Retinal fundus photograph · 2352 x 1568 pixels · 45-degree field of view
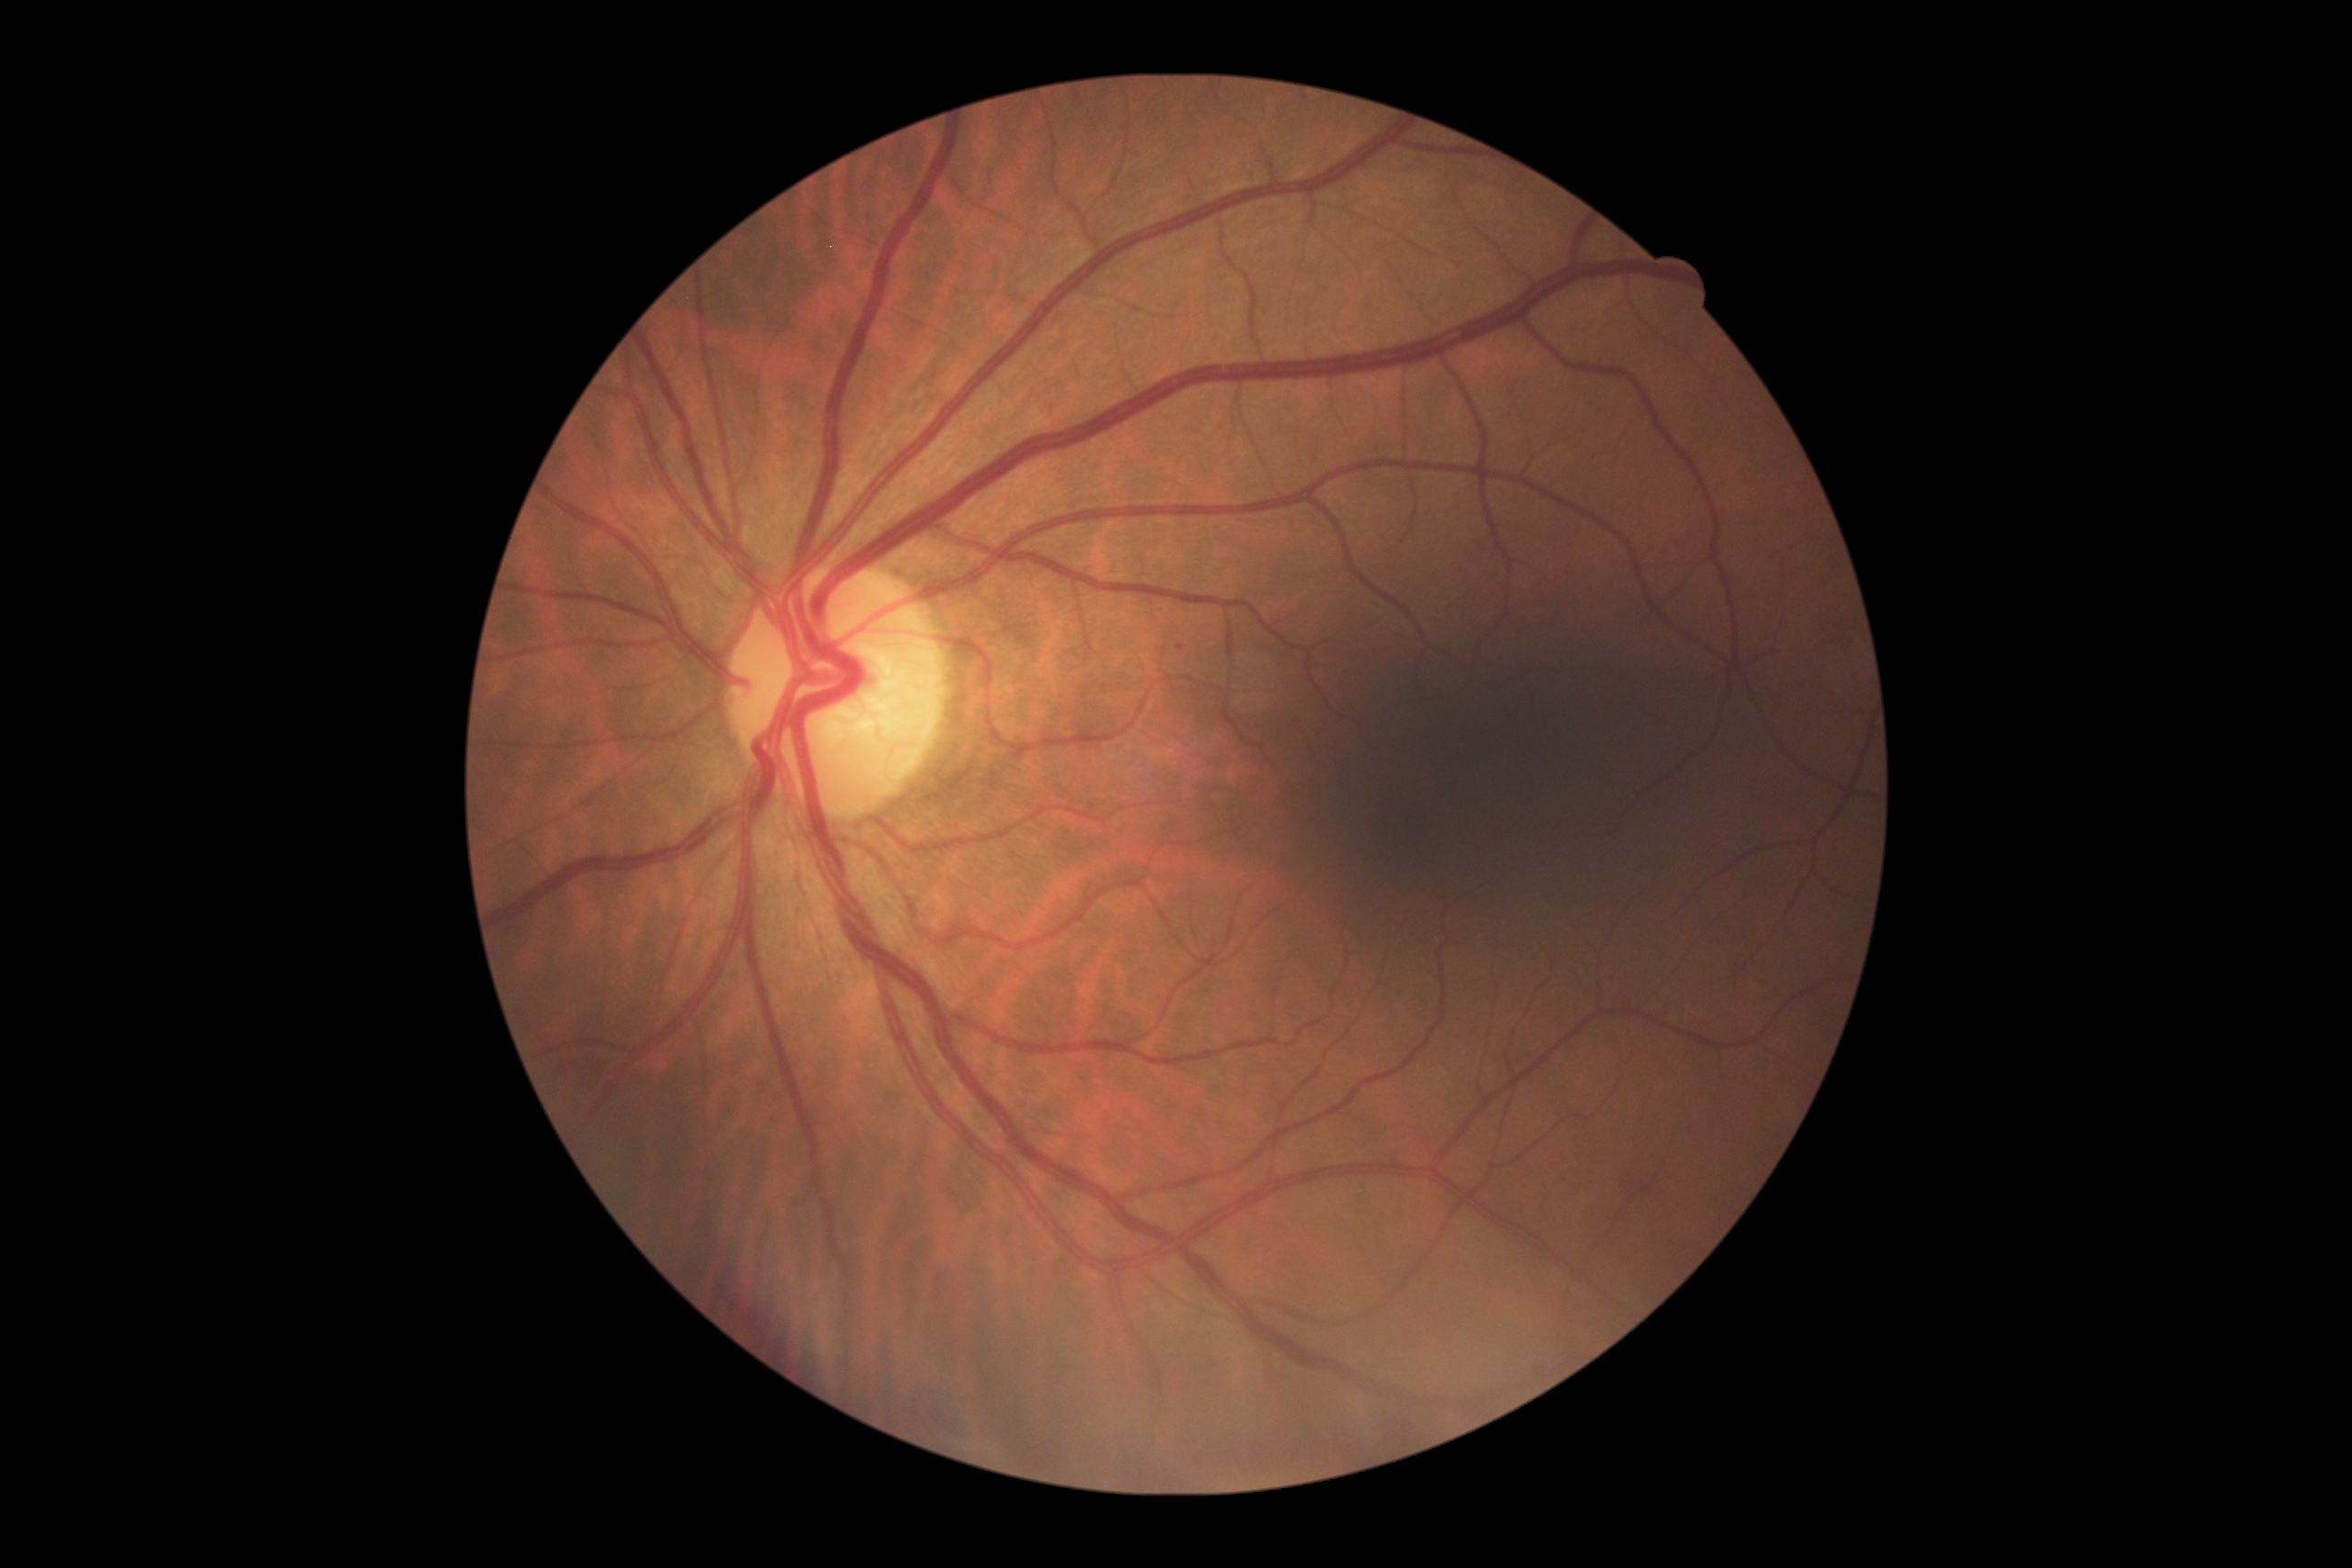

Retinopathy grade is mild NPDR (1).